Topcon TRC retinal camera, IMAGEnet capture system · optic disc photograph
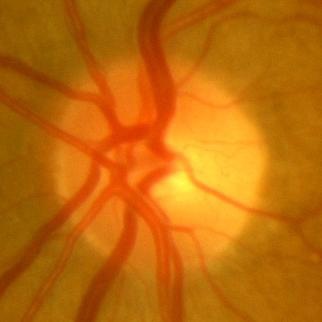
Glaucoma status: no glaucomatous optic neuropathy.